45° FOV.
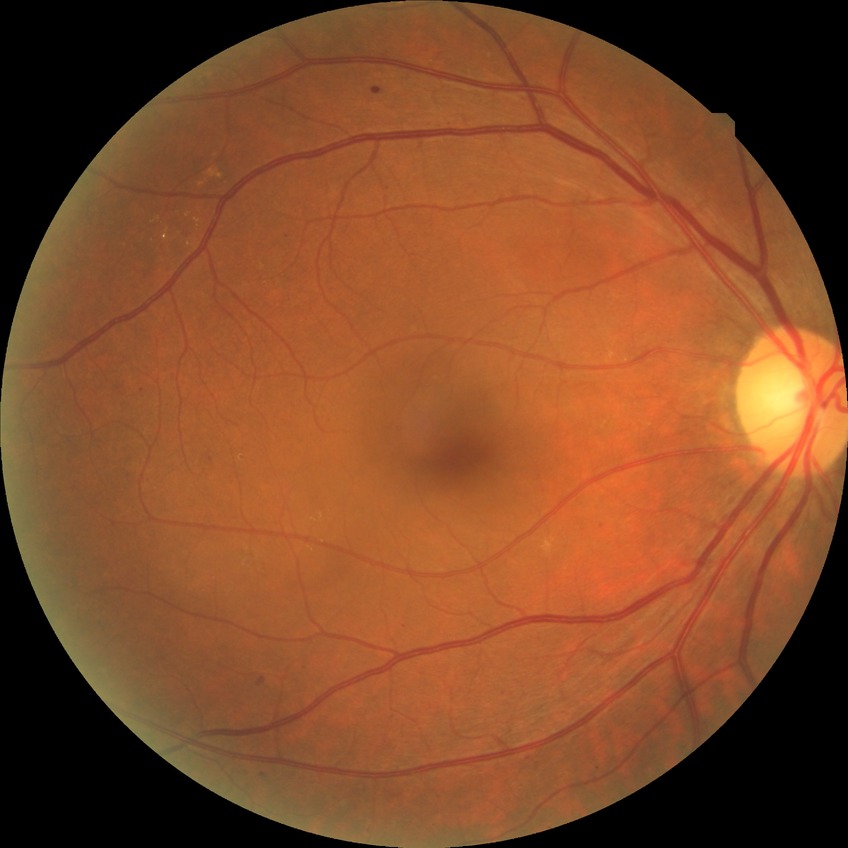

Retinopathy stage is simple diabetic retinopathy.